45° FOV.
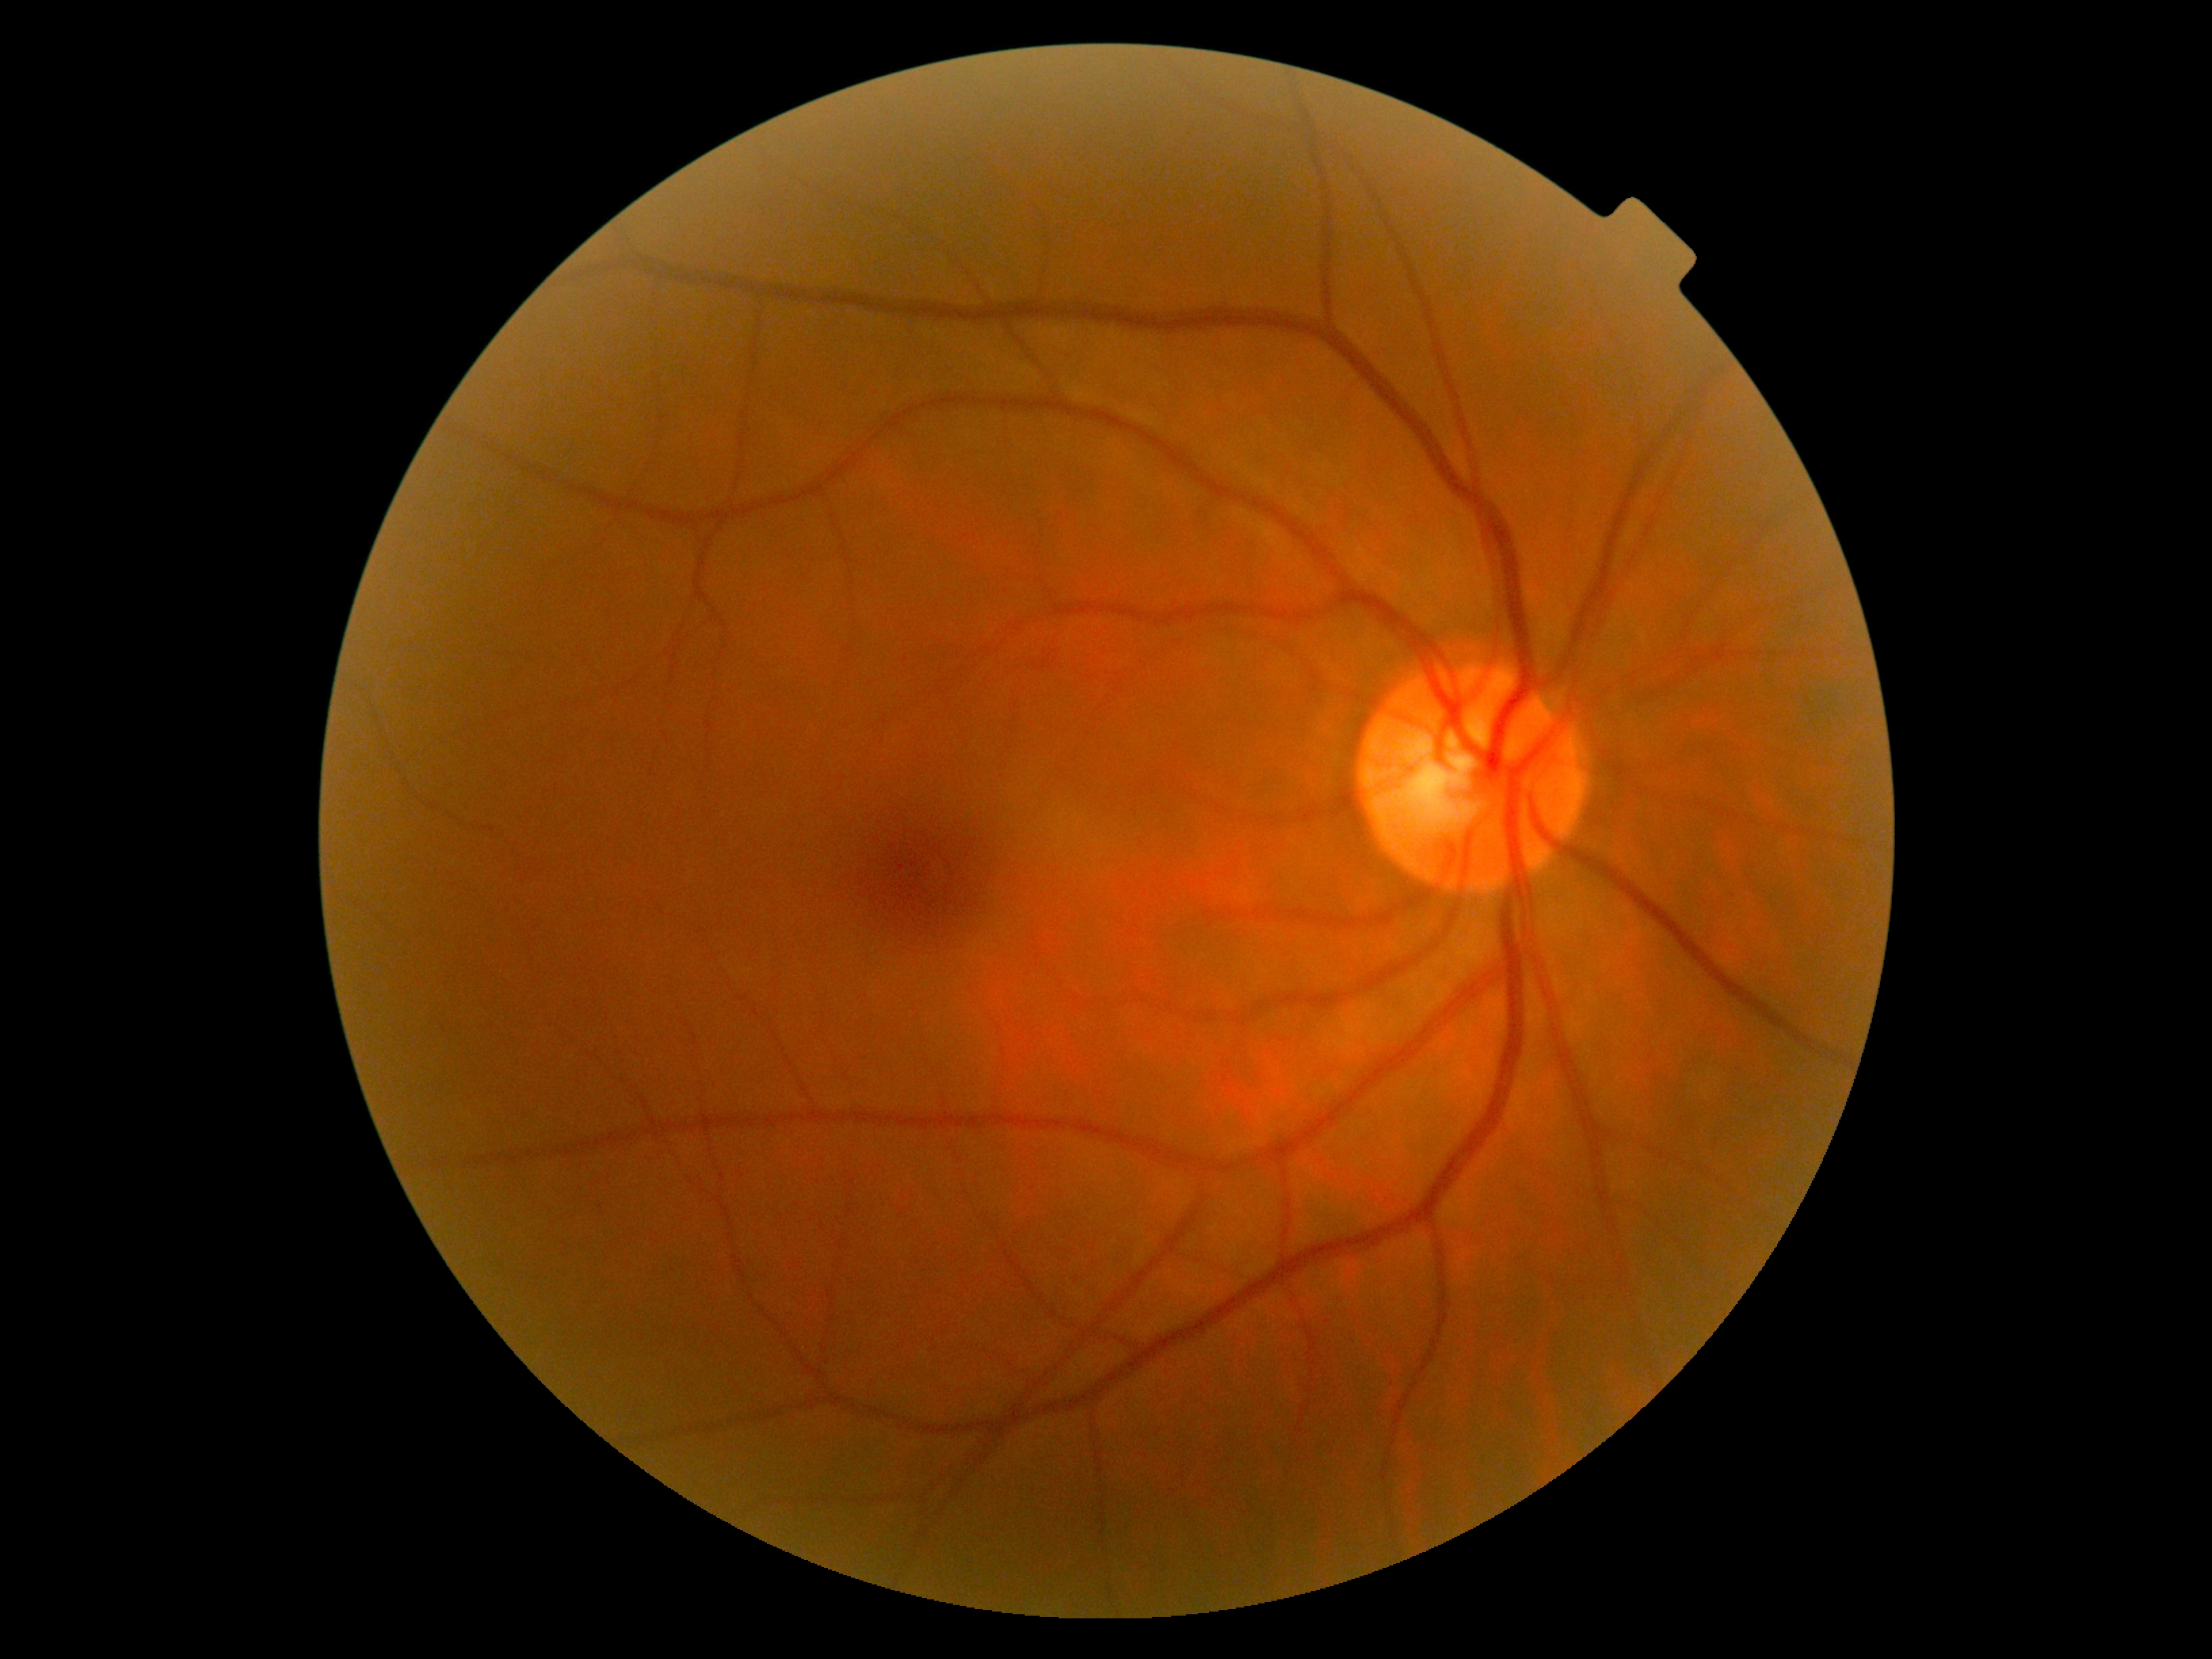
diabetic retinopathy grade: no apparent diabetic retinopathy (0).